Wide-field fundus photograph from neonatal ROP screening.
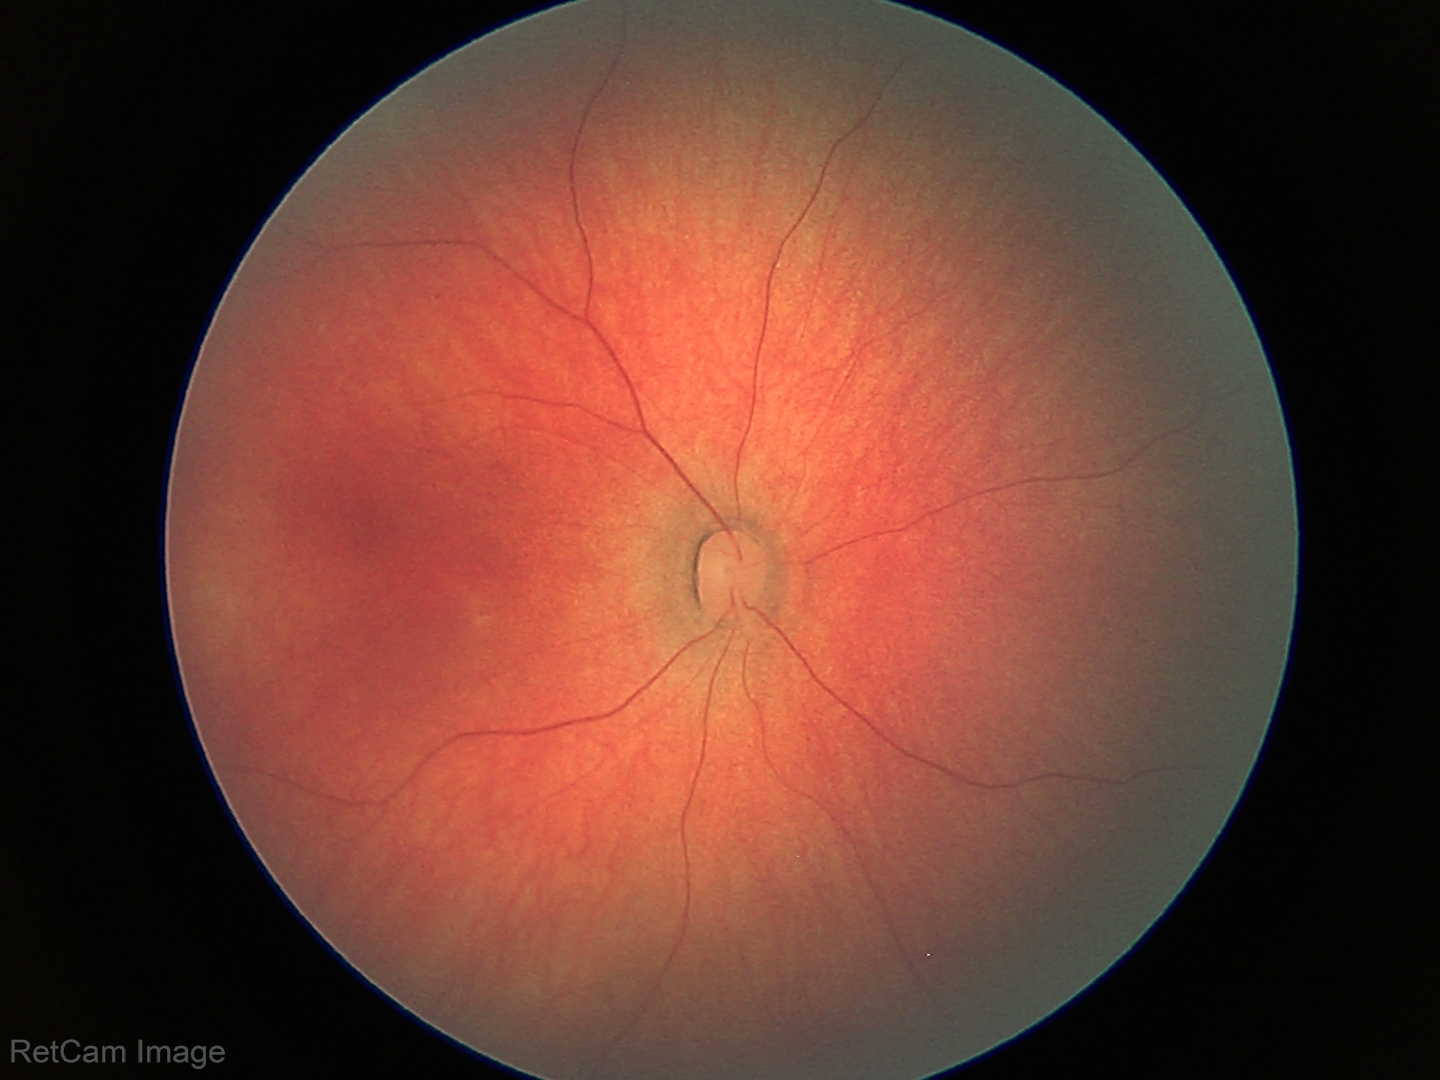 Normal screening examination.